2212 x 1659 pixels.
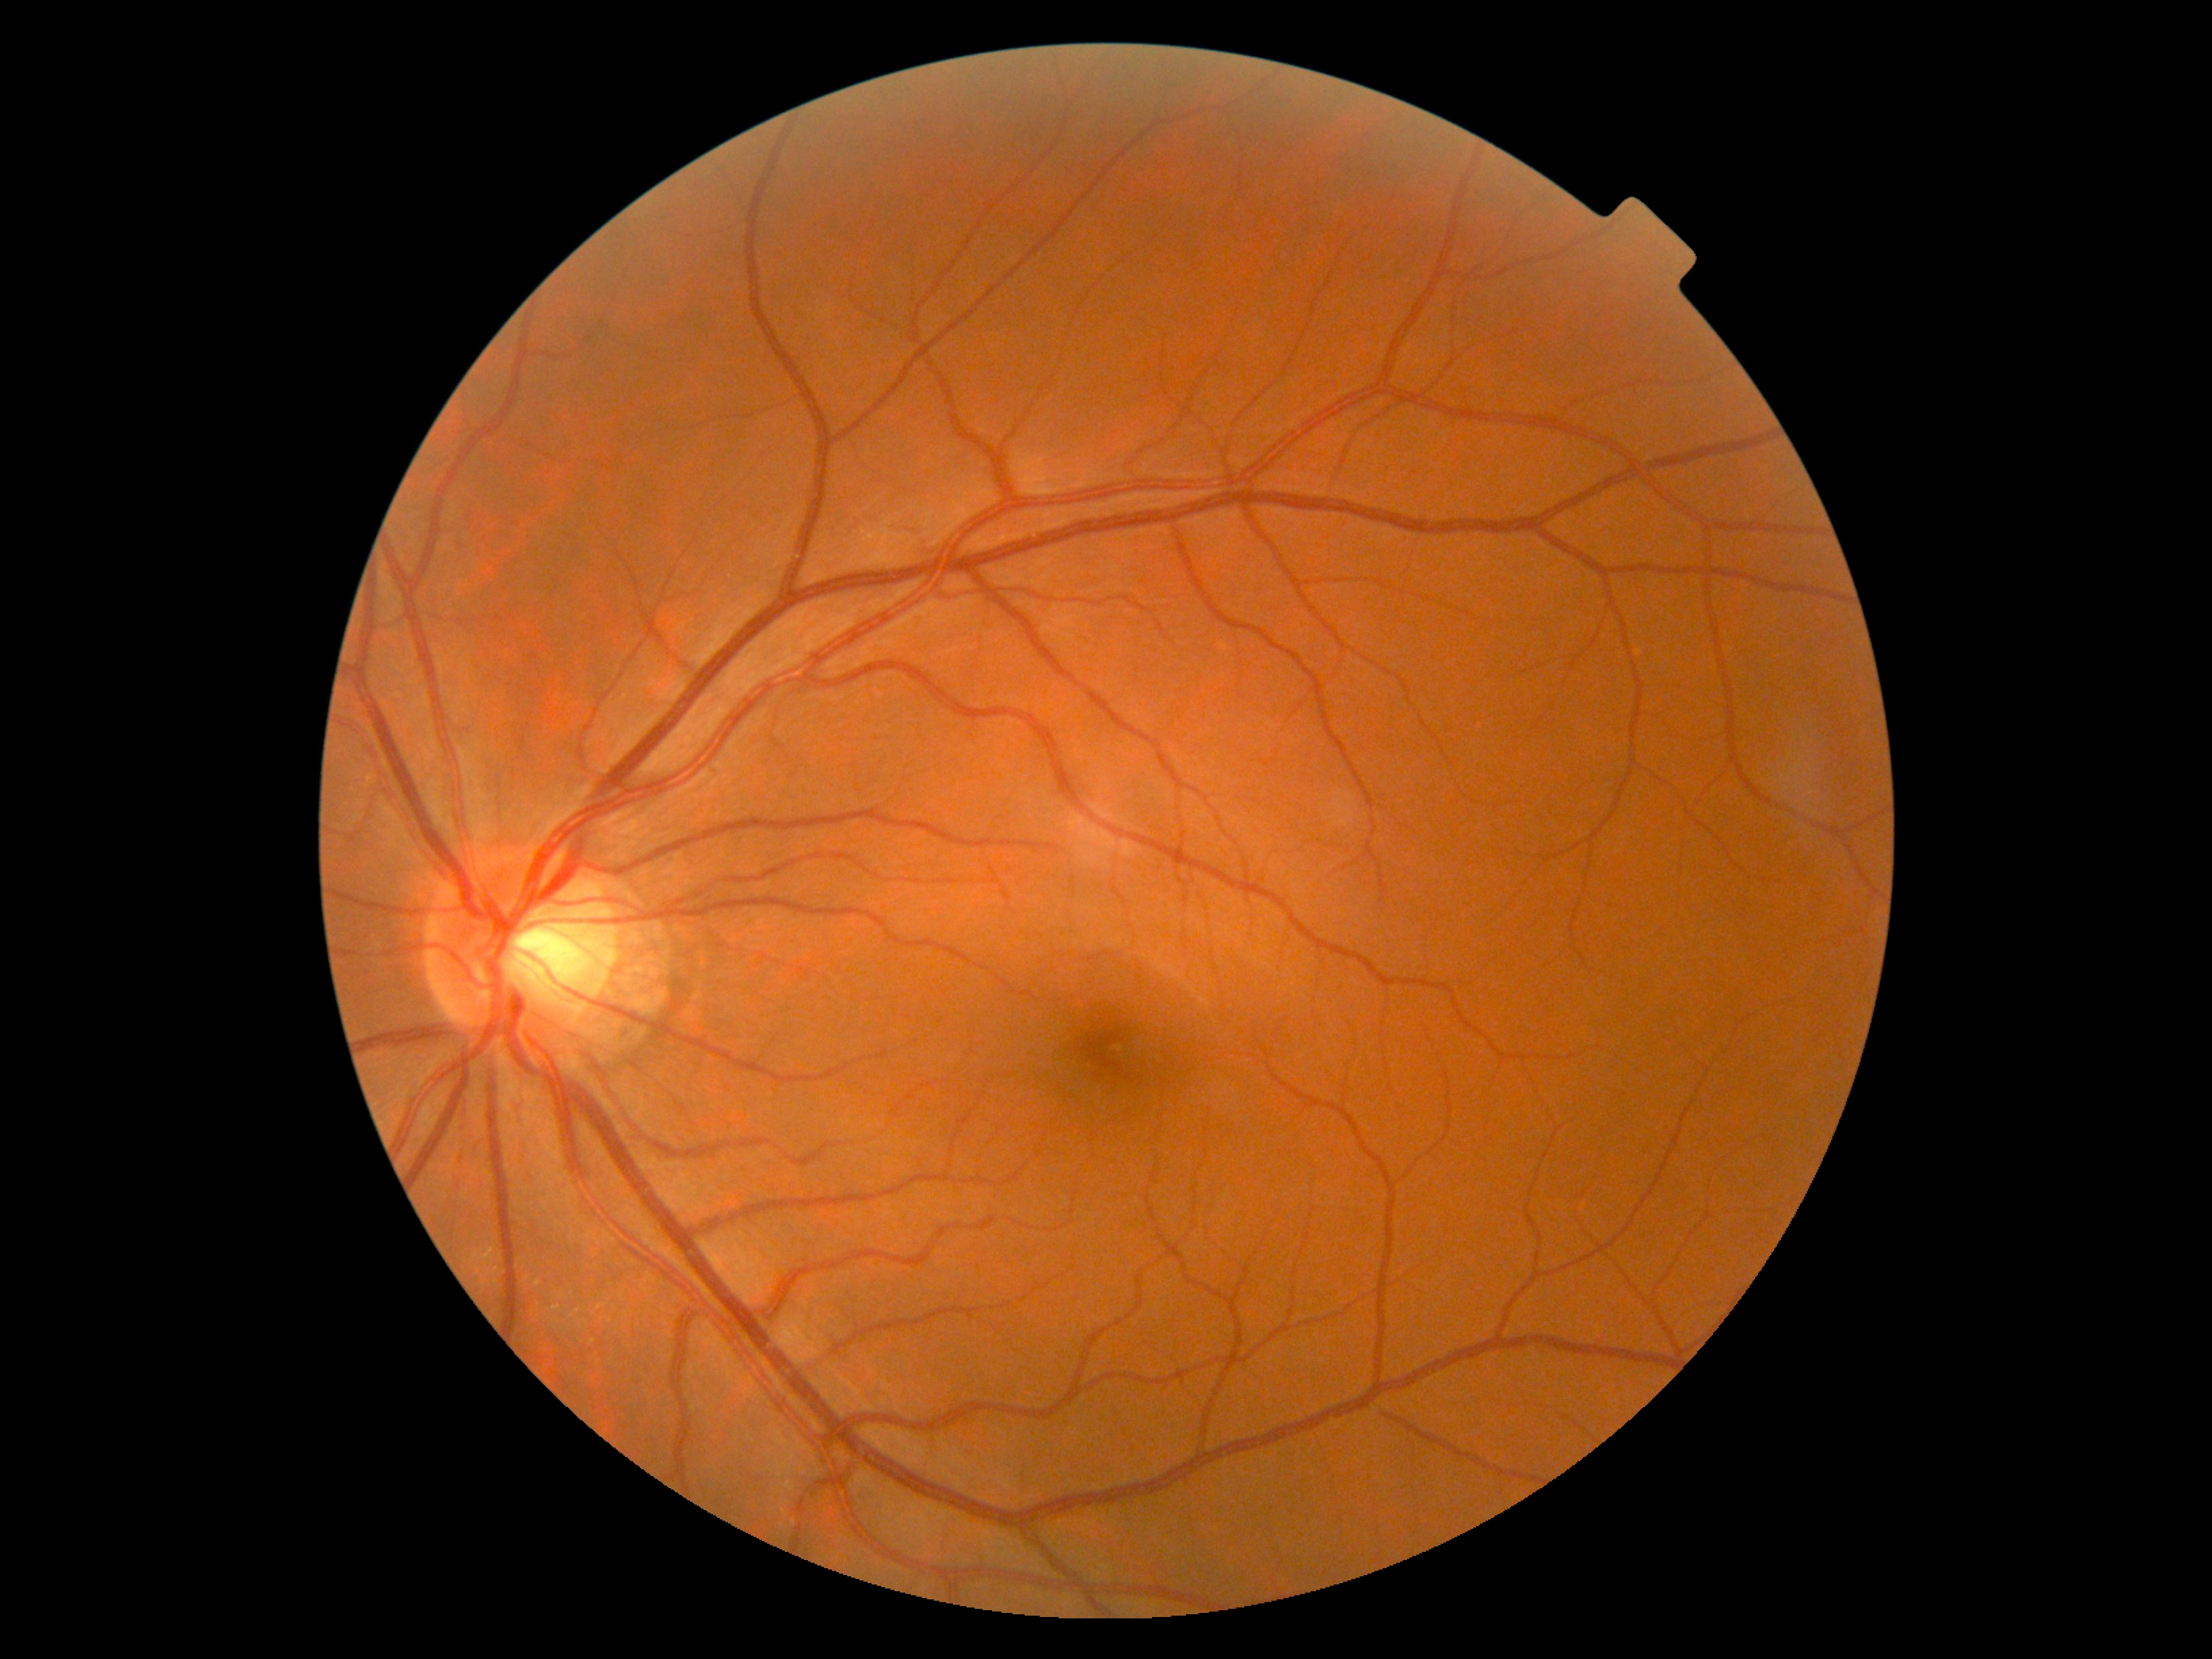 diabetic retinopathy (DR): 0/4